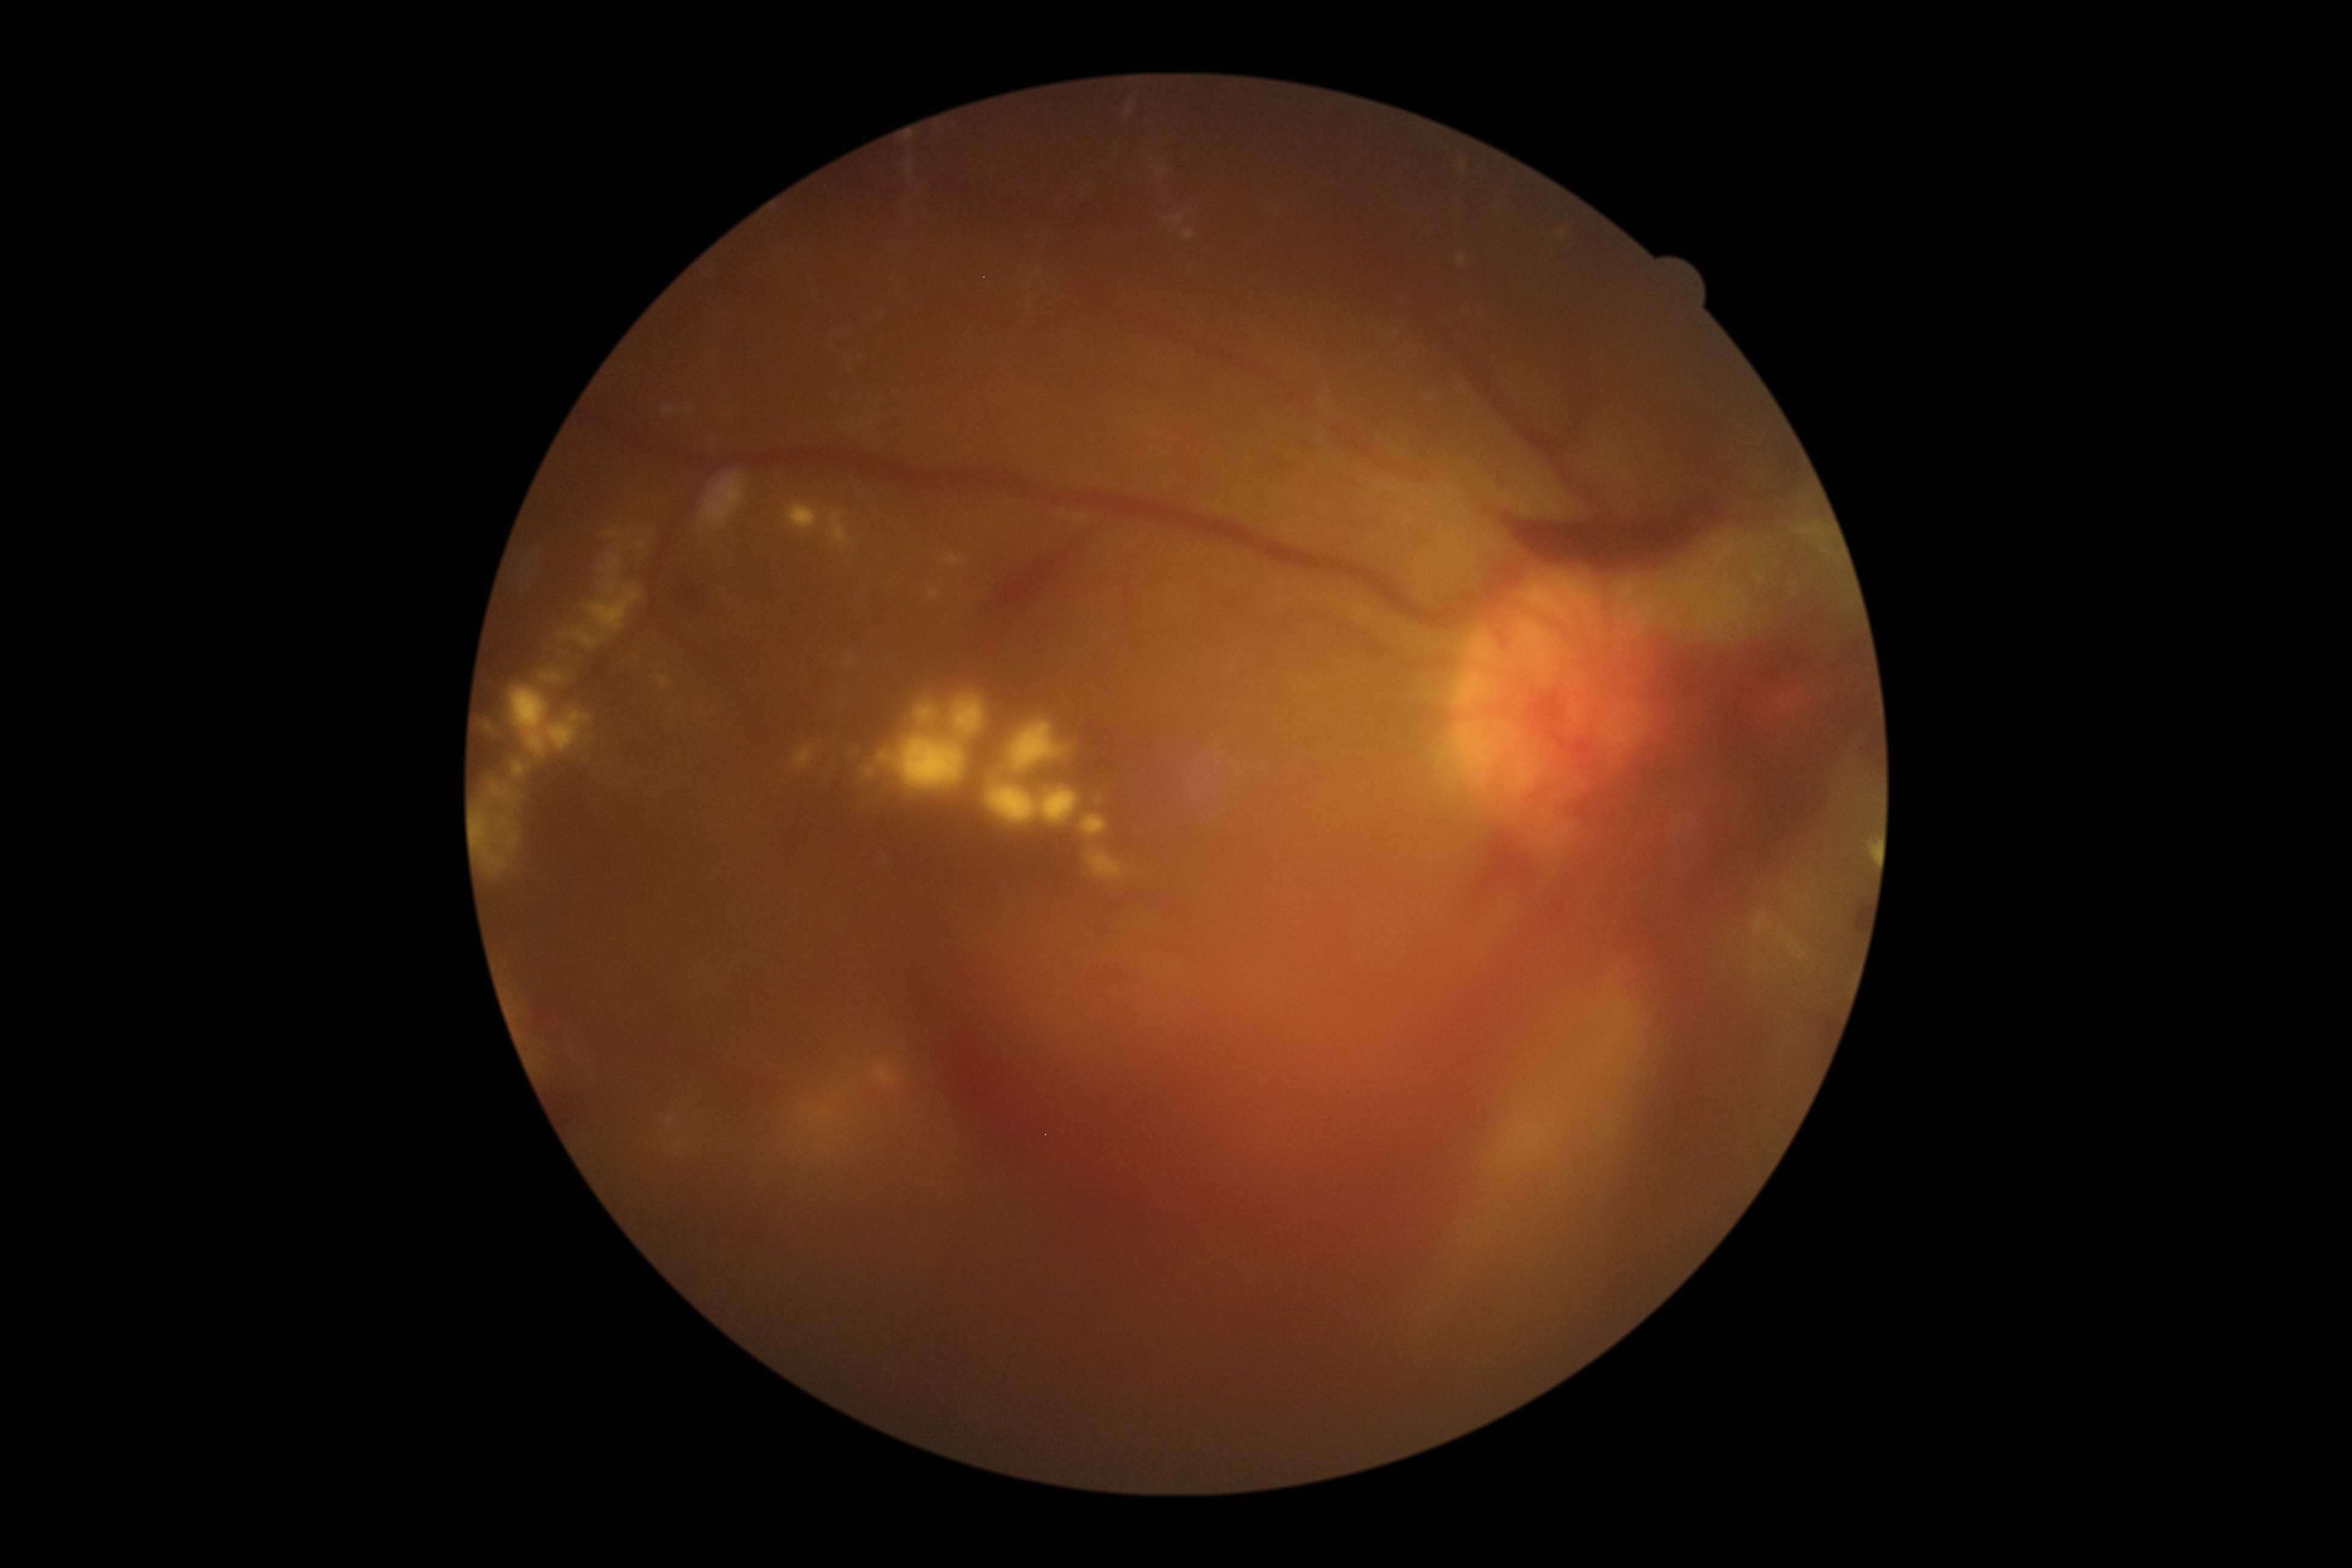 DR grade is 4 (PDR) — neovascularization and/or vitreous/pre-retinal hemorrhage
Lesions identified (partial list):
MAs: absent
EXs: rect(746, 1060, 909, 1190), rect(493, 943, 583, 1088), rect(654, 1105, 713, 1175), rect(475, 515, 658, 890), rect(776, 489, 1127, 886), rect(1461, 1074, 1567, 1235), rect(1872, 844, 1877, 860)
SEs: absent
HEs (subset): rect(667, 567, 724, 630), rect(1819, 1053, 1825, 1067), rect(802, 622, 1877, 1341), rect(1473, 488, 1728, 573), rect(725, 157, 1221, 256), rect(972, 523, 1108, 641), rect(1808, 1022, 1837, 1050), rect(1841, 898, 1870, 943), rect(483, 775, 787, 1126)